Color fundus photograph
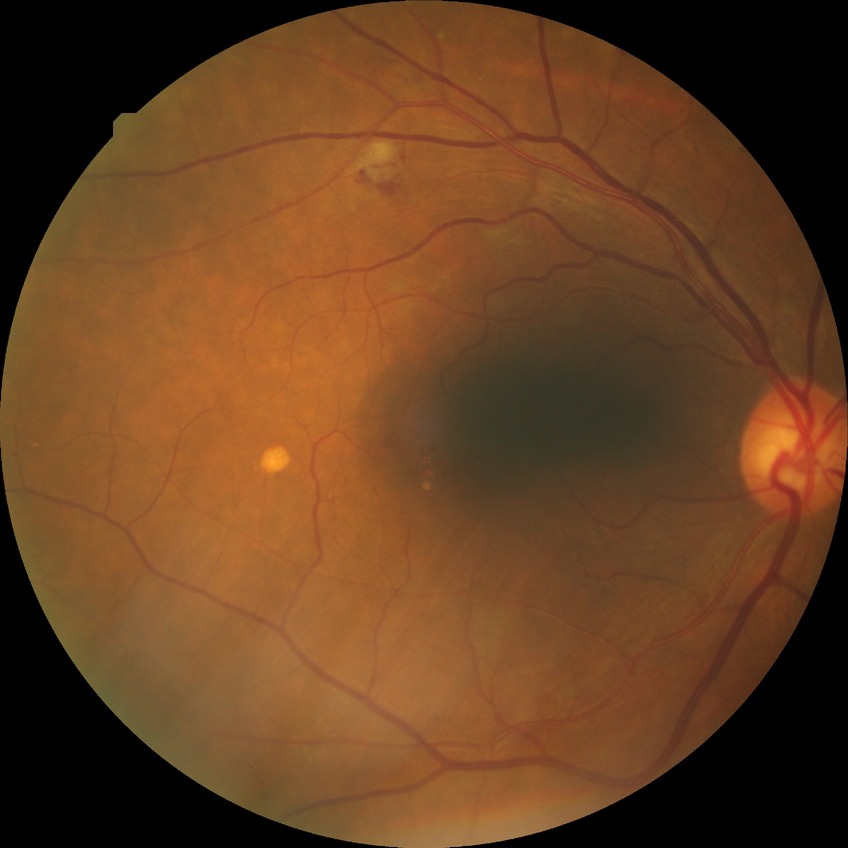 diabetic retinopathy (DR)@PPDR (pre-proliferative diabetic retinopathy), DR class@non-proliferative diabetic retinopathy.